Phoenix ICON, 100° FOV. Wide-field fundus image from infant ROP screening.
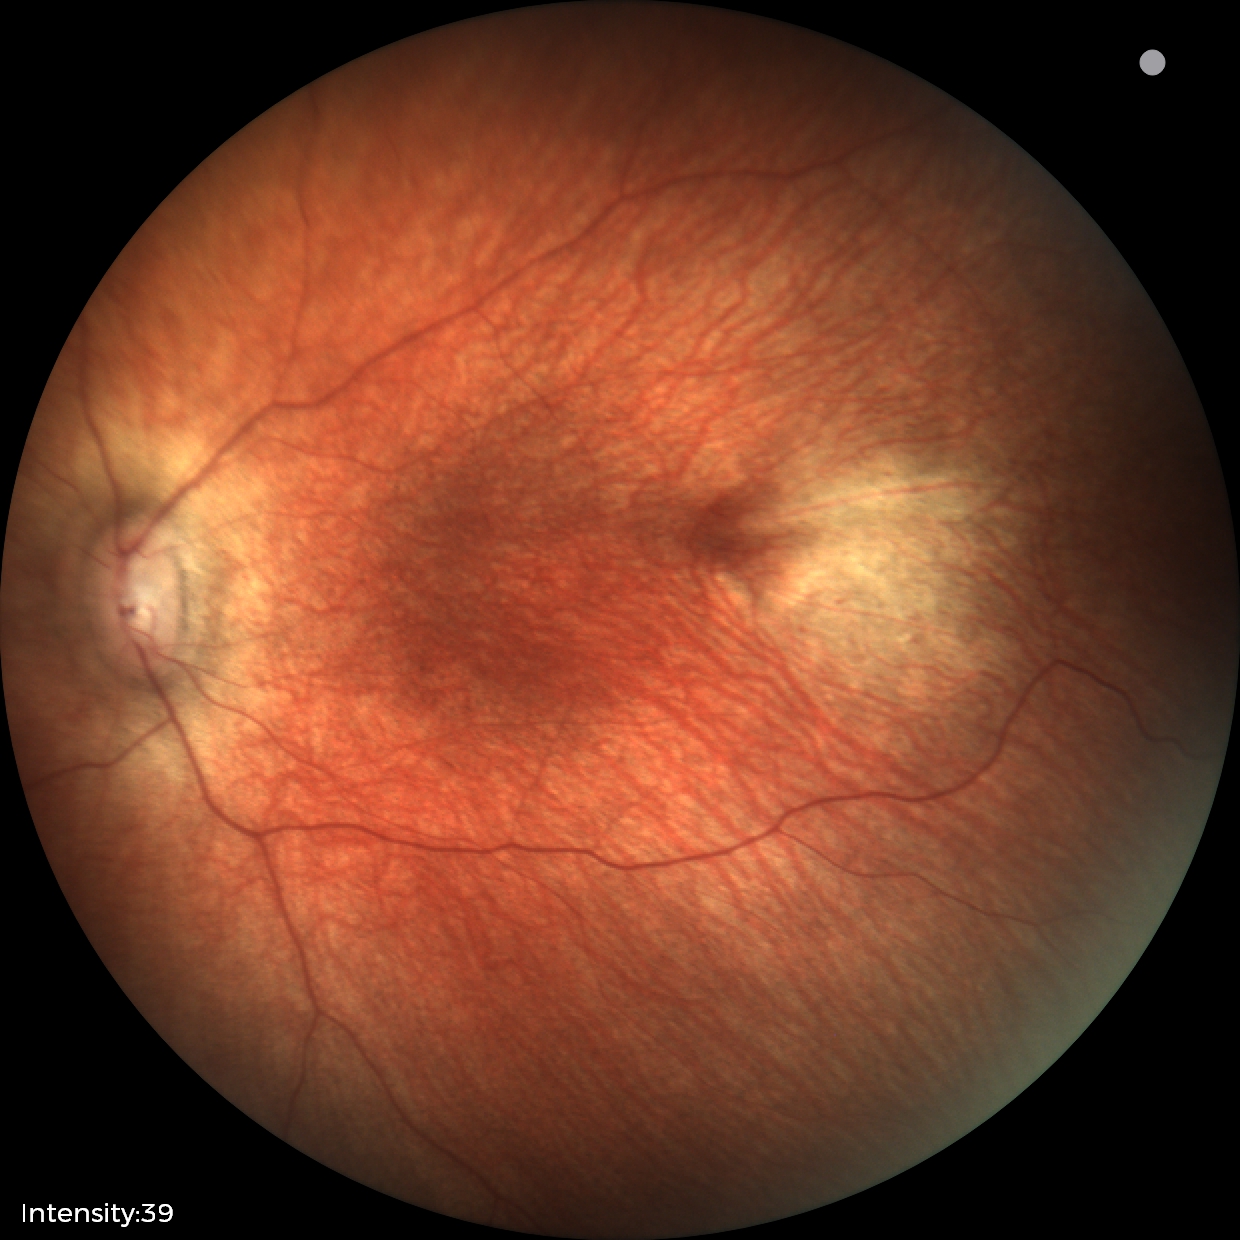
Q: What is the diagnosis from this examination?
A: no abnormal retinal findings